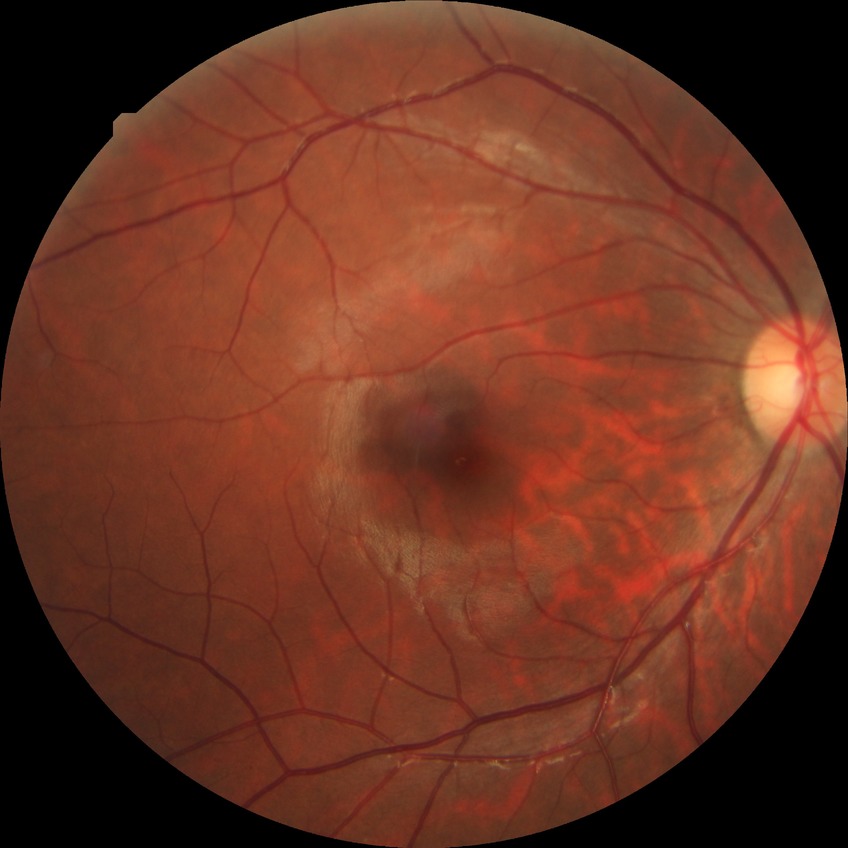 Annotations:
- diabetic retinopathy (DR) — NDR (no diabetic retinopathy)